Image size 1440x1080 · pediatric wide-field fundus photograph — 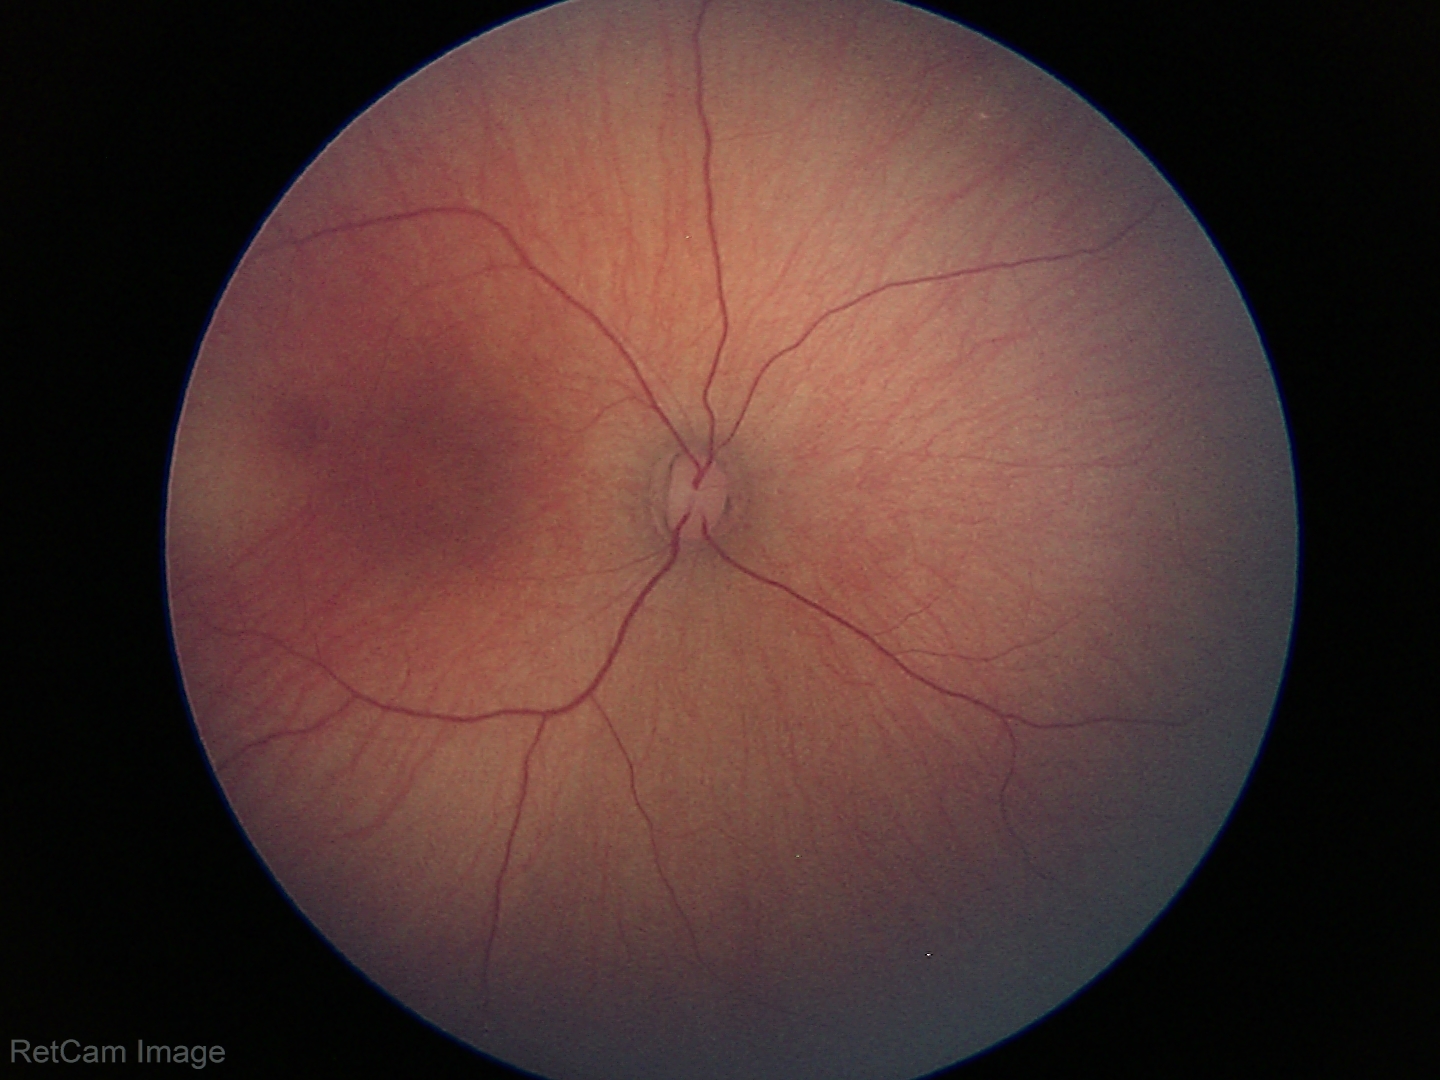
Screening examination with no abnormal retinal findings.